45° FOV, 2352 by 1568 pixels
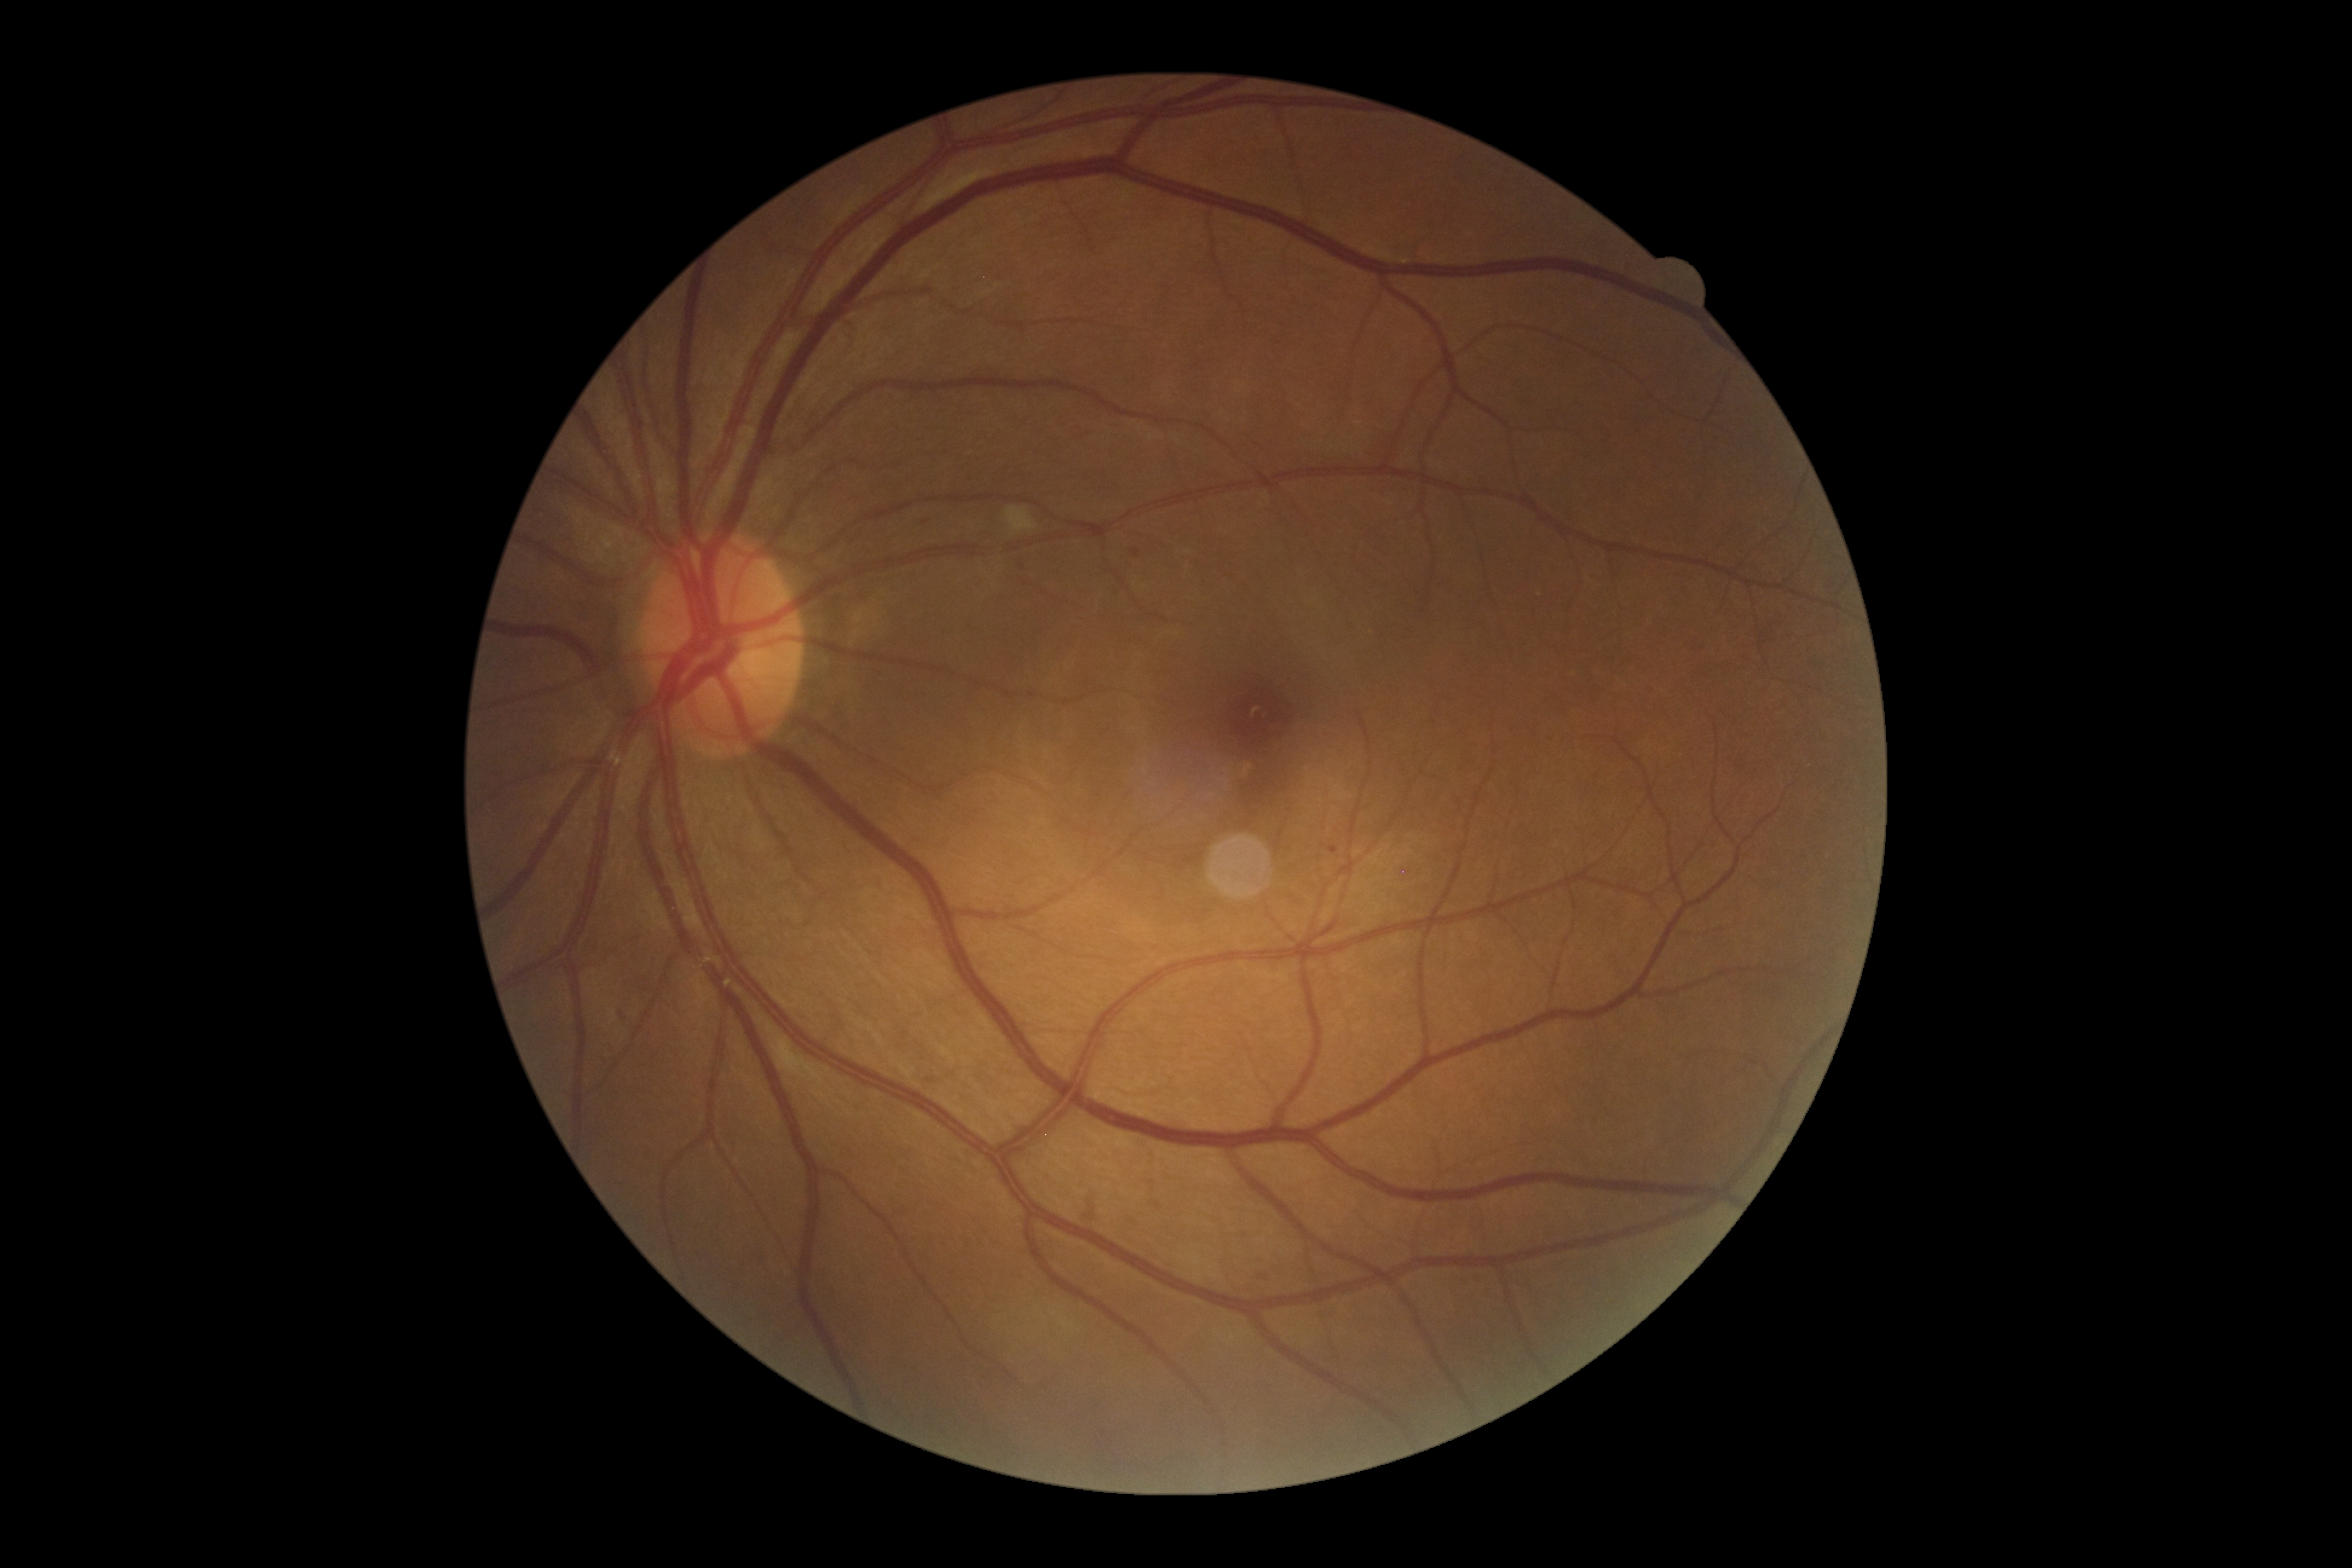

{"dr_category": "non-proliferative diabetic retinopathy", "dr_grade": "2"}